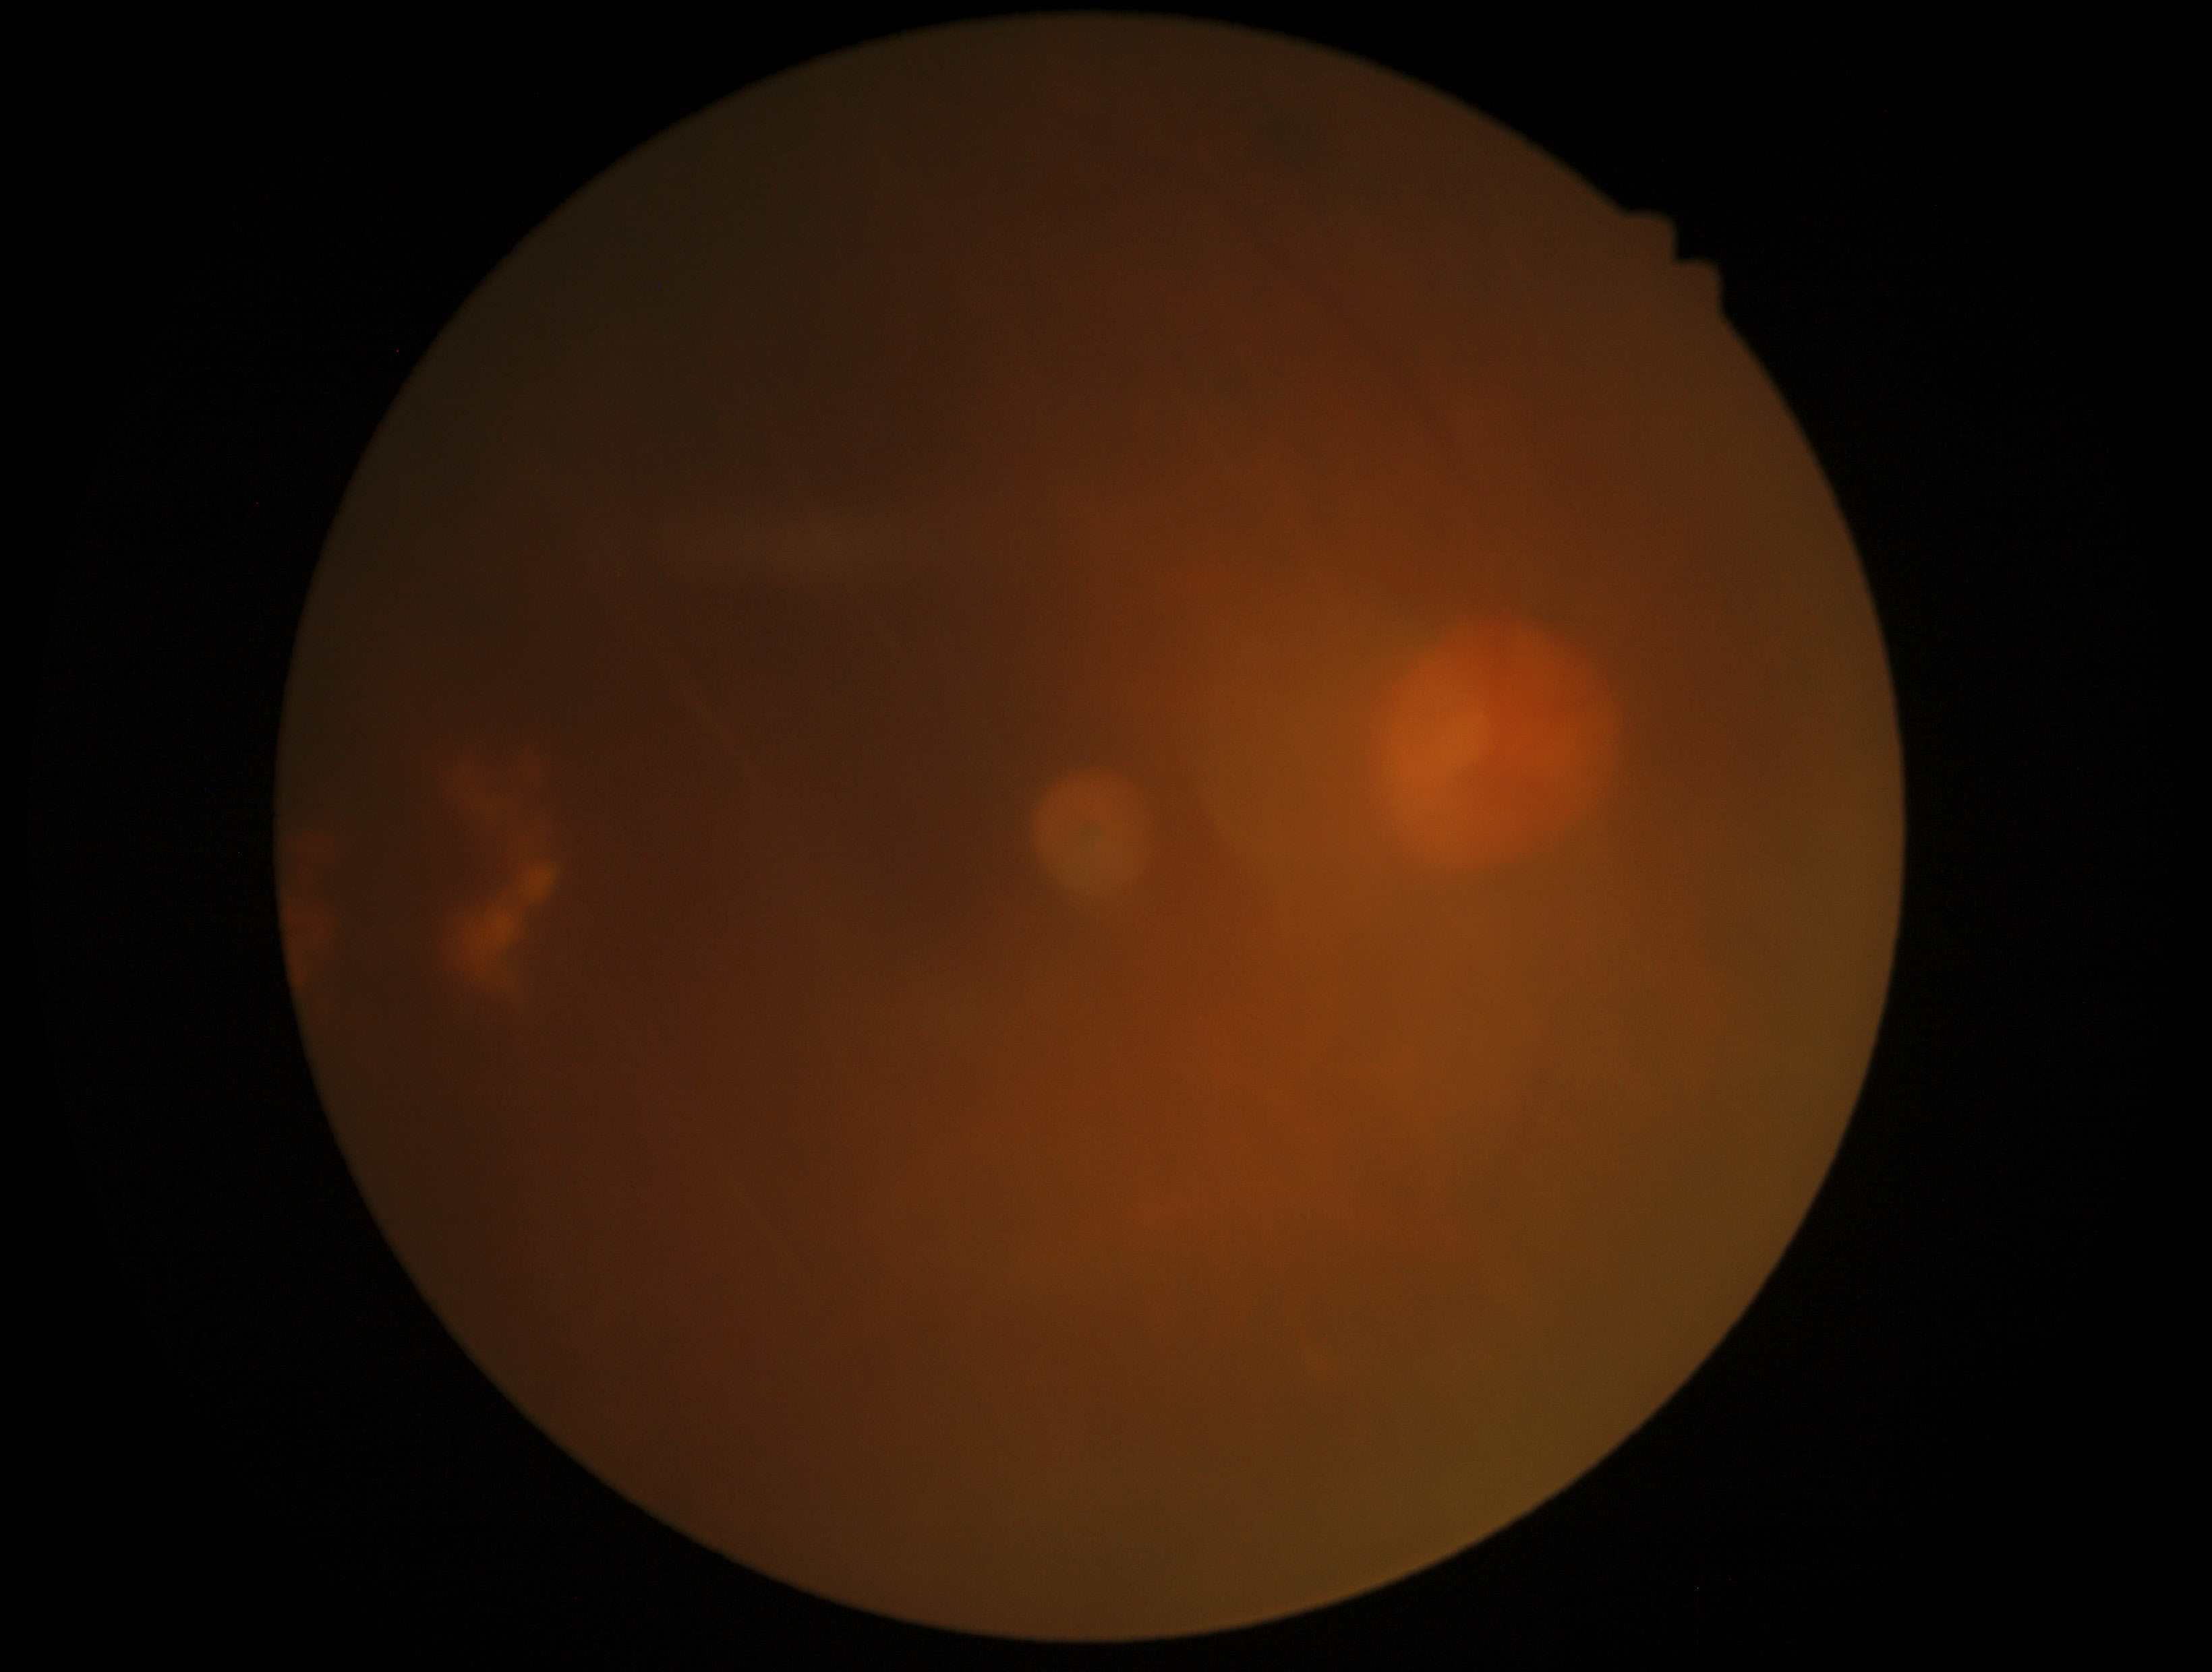
Diabetic retinopathy: 2/4.